CFP.
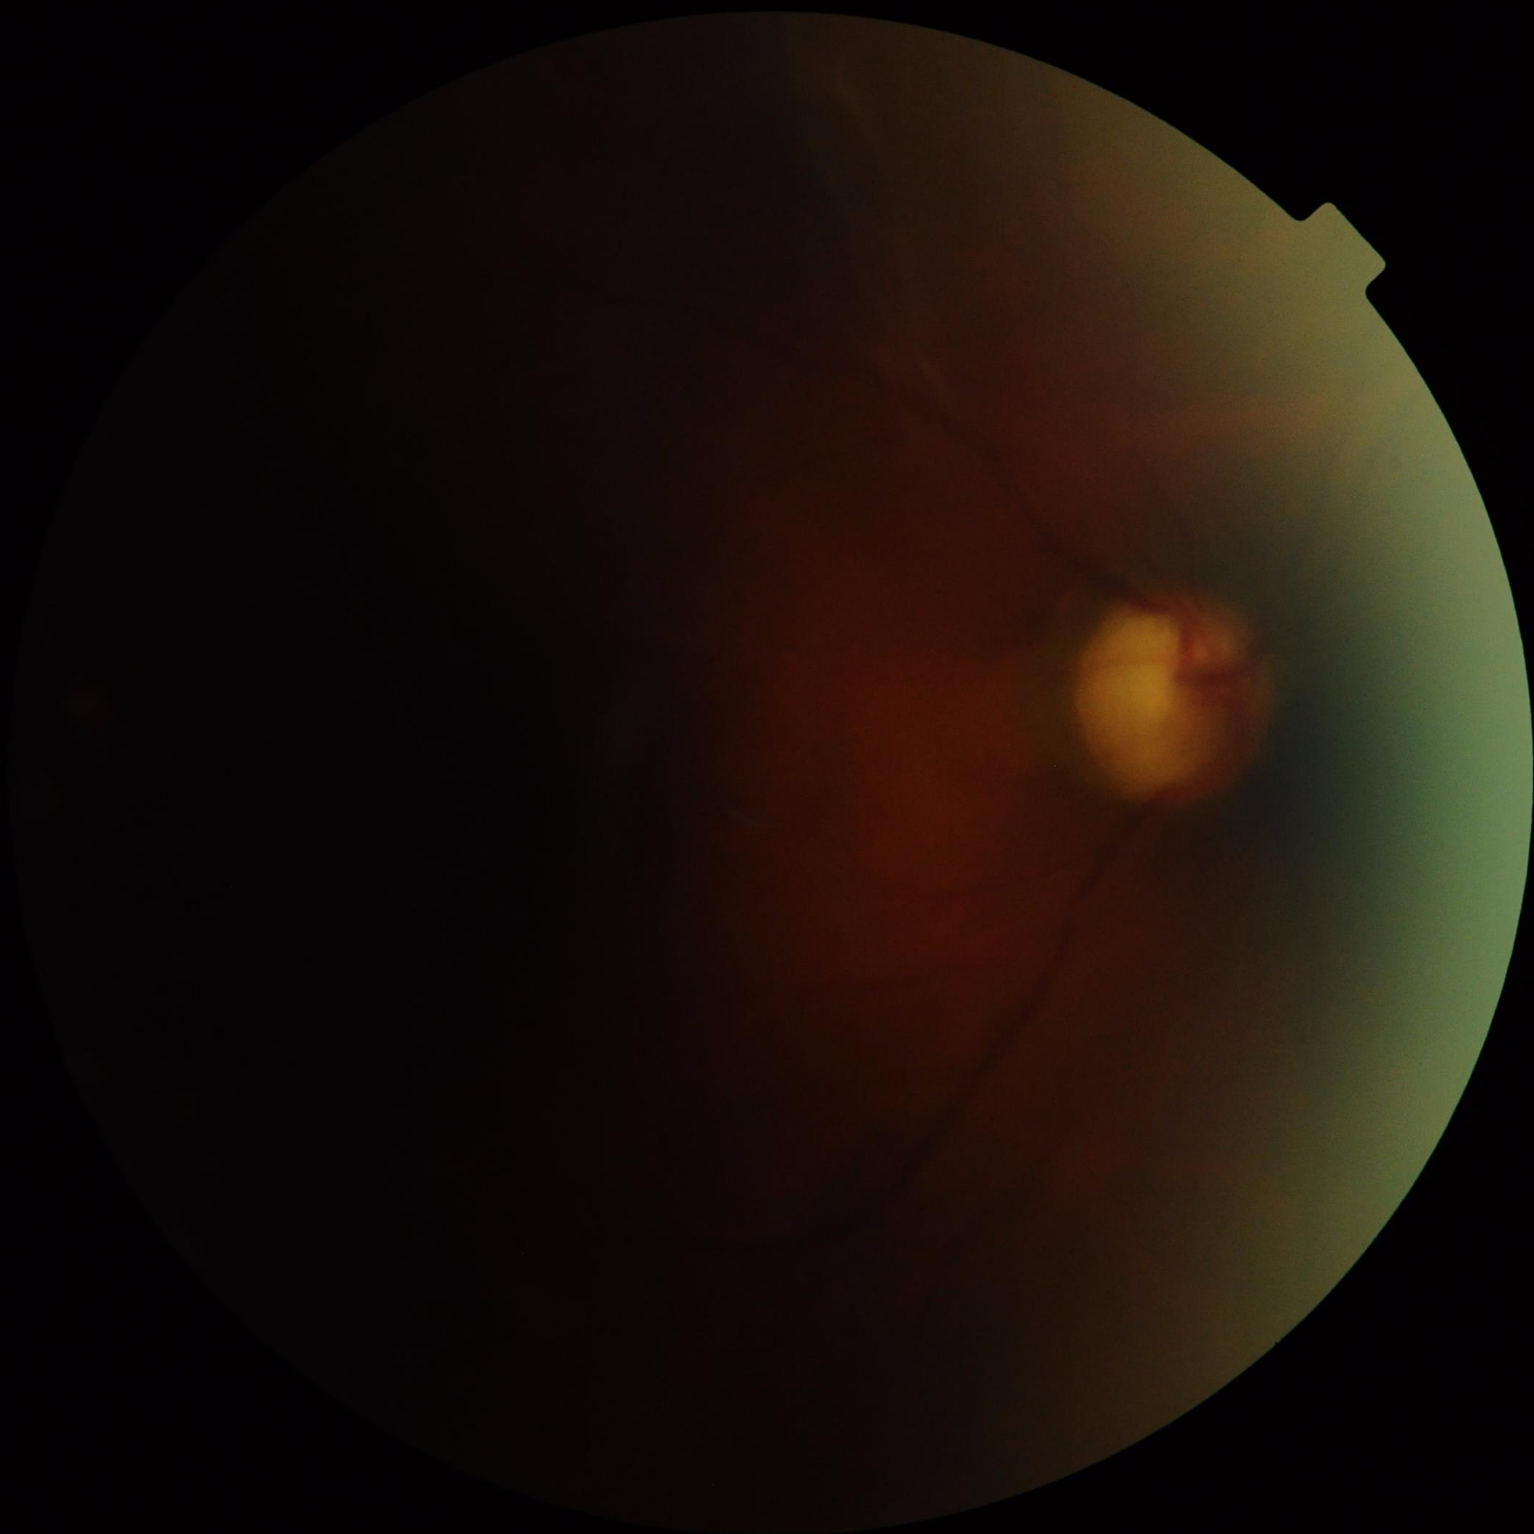

Quality assessment:
- overall: poor and difficult to use diagnostically
- contrast: poor dynamic range
- sharpness: noticeable blur in the optic disc, vessels, or background
- illumination: over- or under-exposed